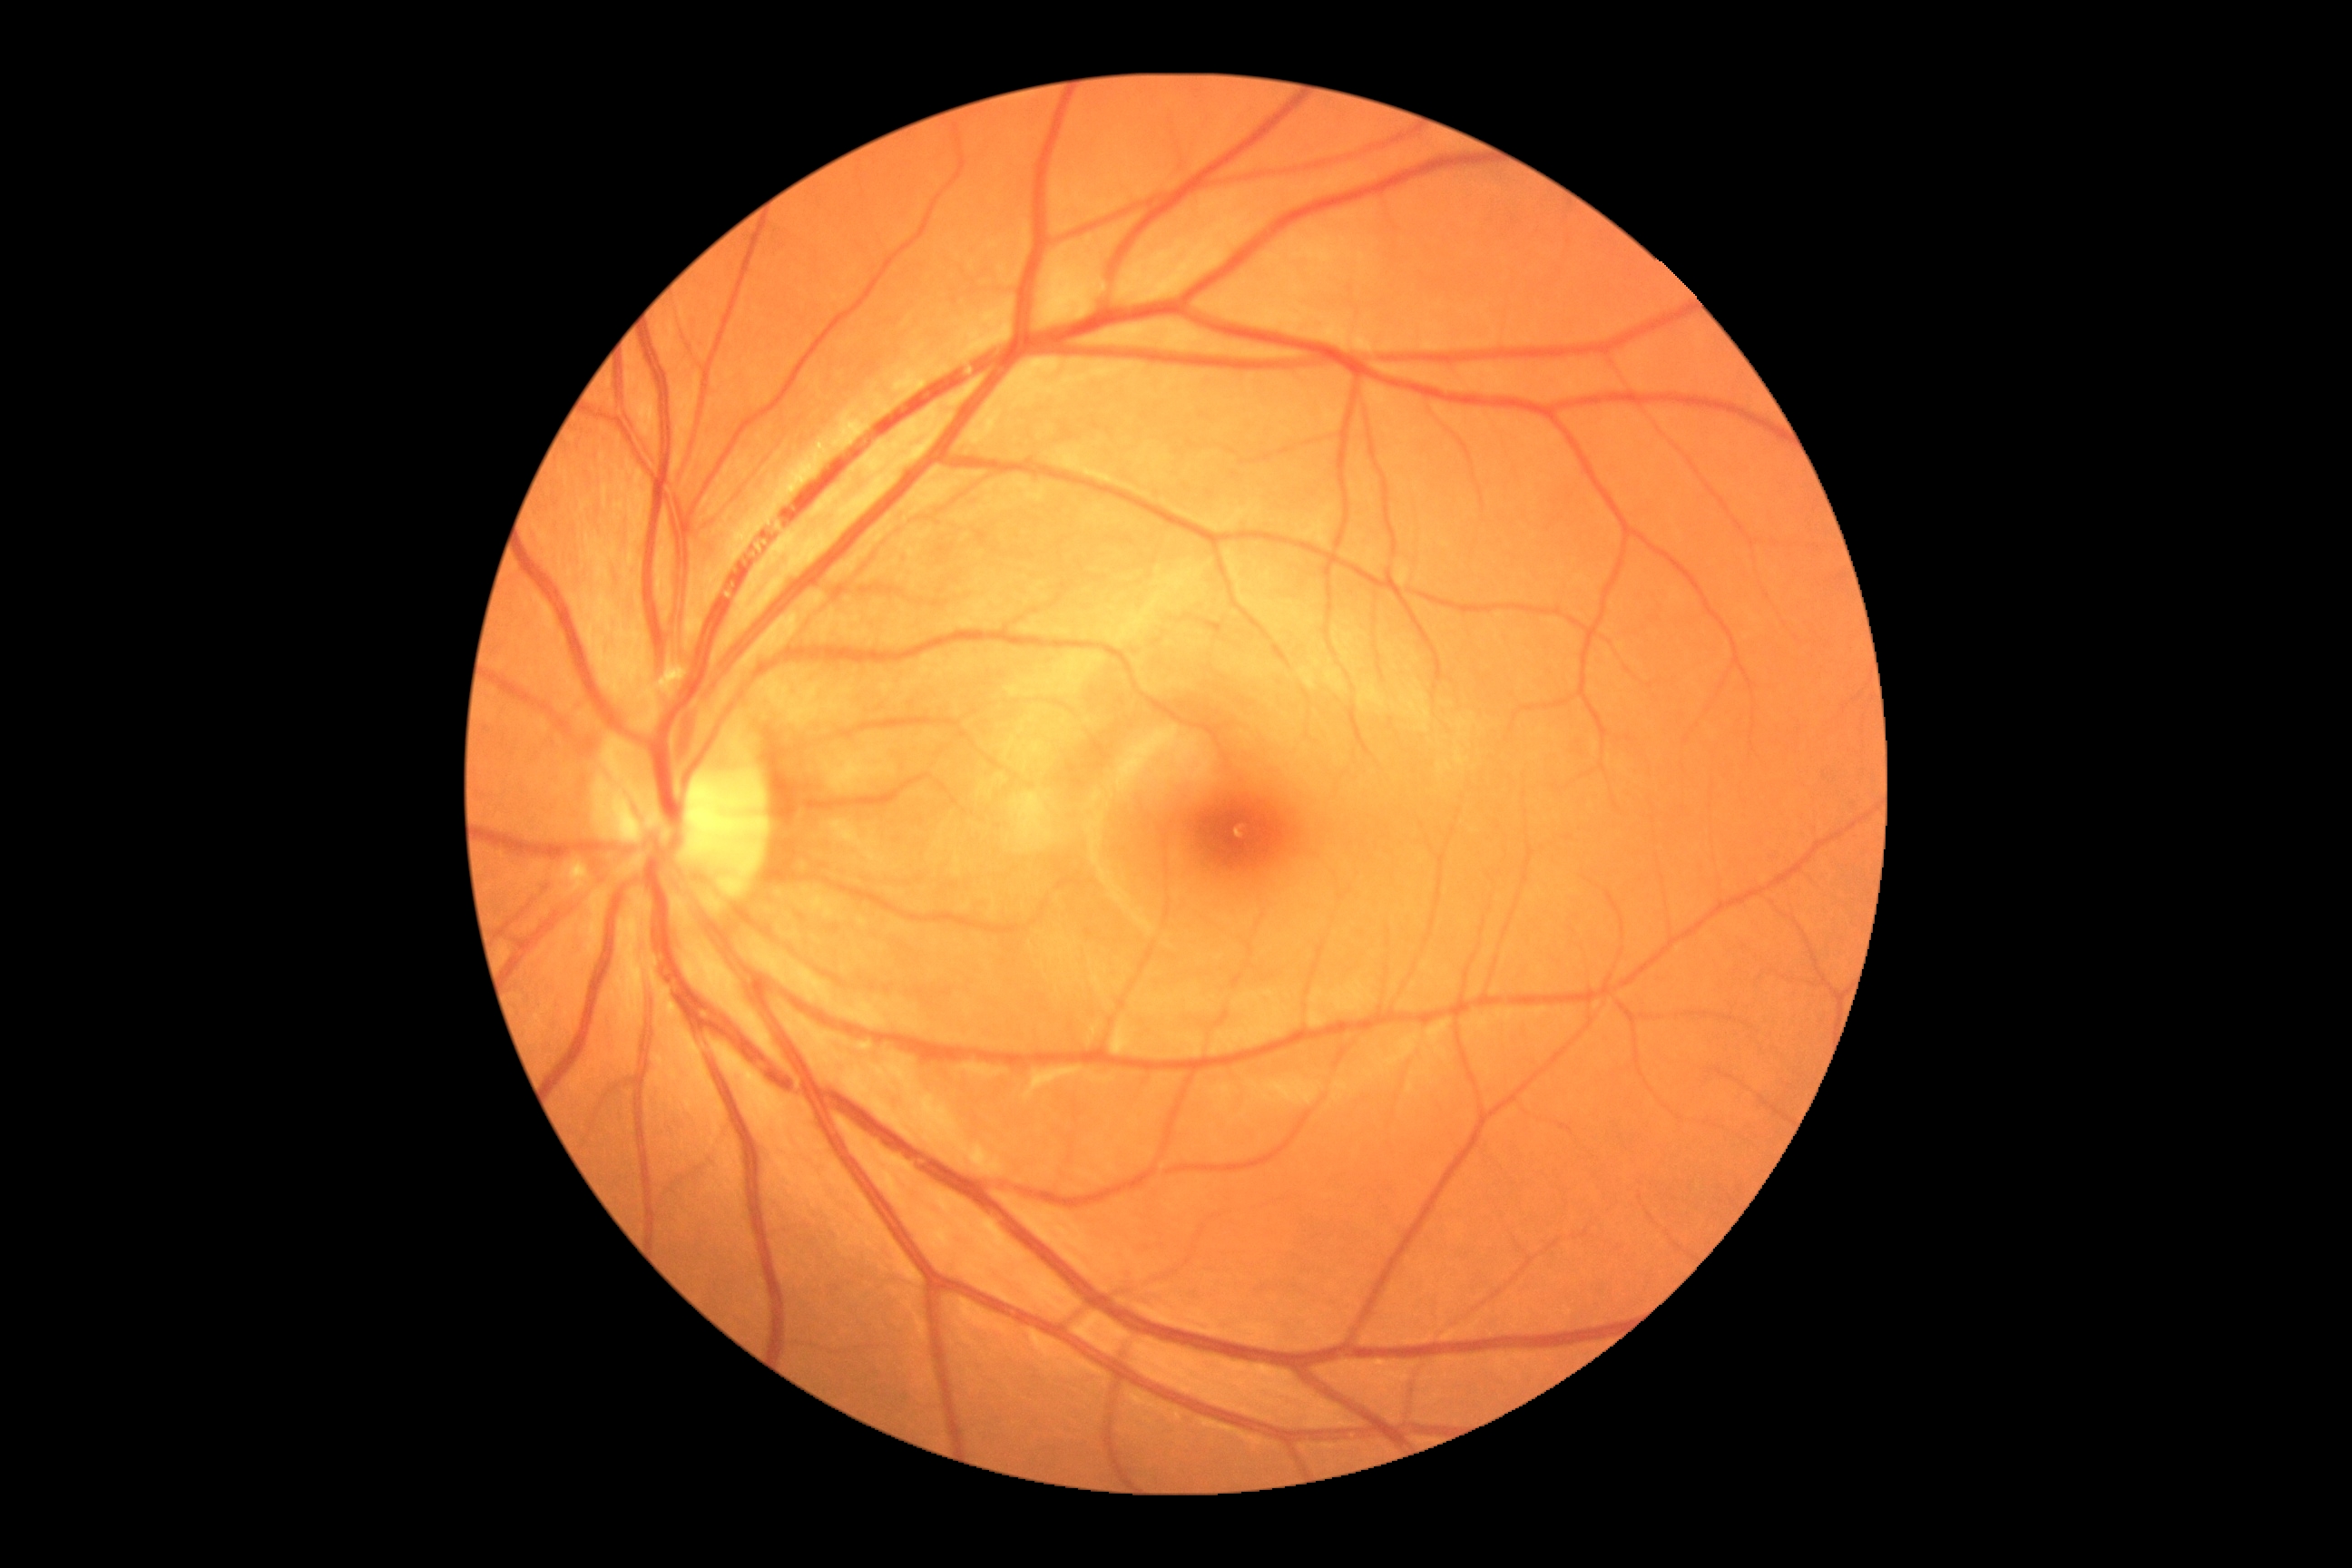 Diabetic retinopathy (DR): no apparent diabetic retinopathy (grade 0).